640x480; wide-field fundus photograph of an infant; captured with the Clarity RetCam 3 (130° field of view): 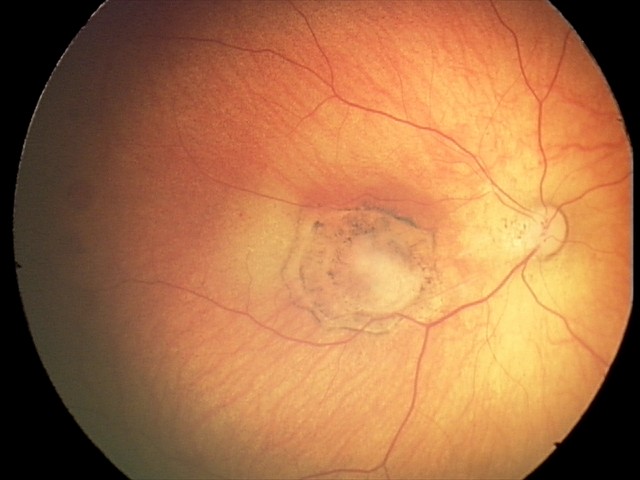

From an examination with diagnosis of toxoplasmosis chorioretinitis.